Pediatric wide-field fundus photograph. Camera: Clarity RetCam 3 (130° FOV)
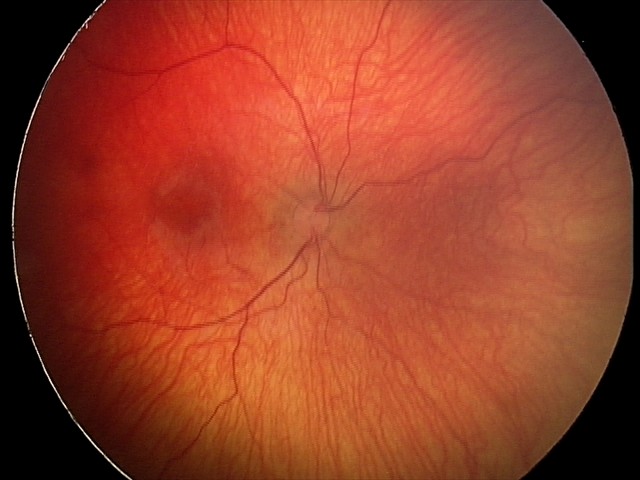

Screening series with status post ROP. Plus disease absent.